Image size 412x310, 45-degree field of view:
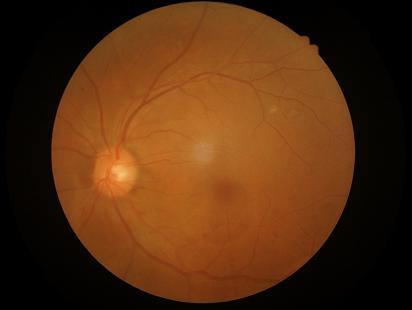 Illumination/color = even | Contrast = good | Focus = good | Overall image quality = satisfactory.